Optic disc-centered crop from a color fundus photograph · captured with pupil dilation — 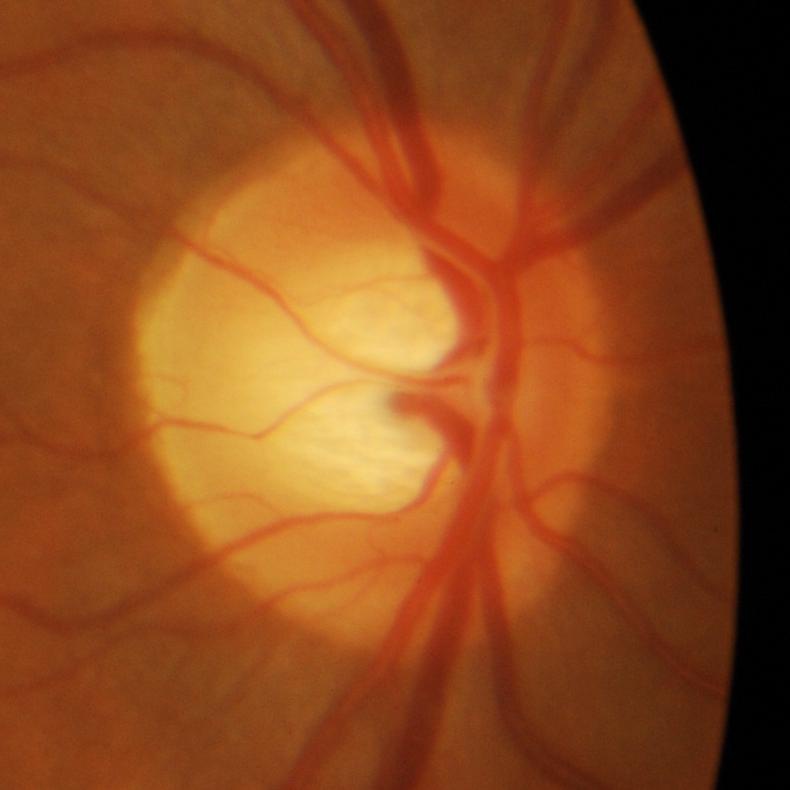 Glaucomatous changes.